FOV: 45 degrees: 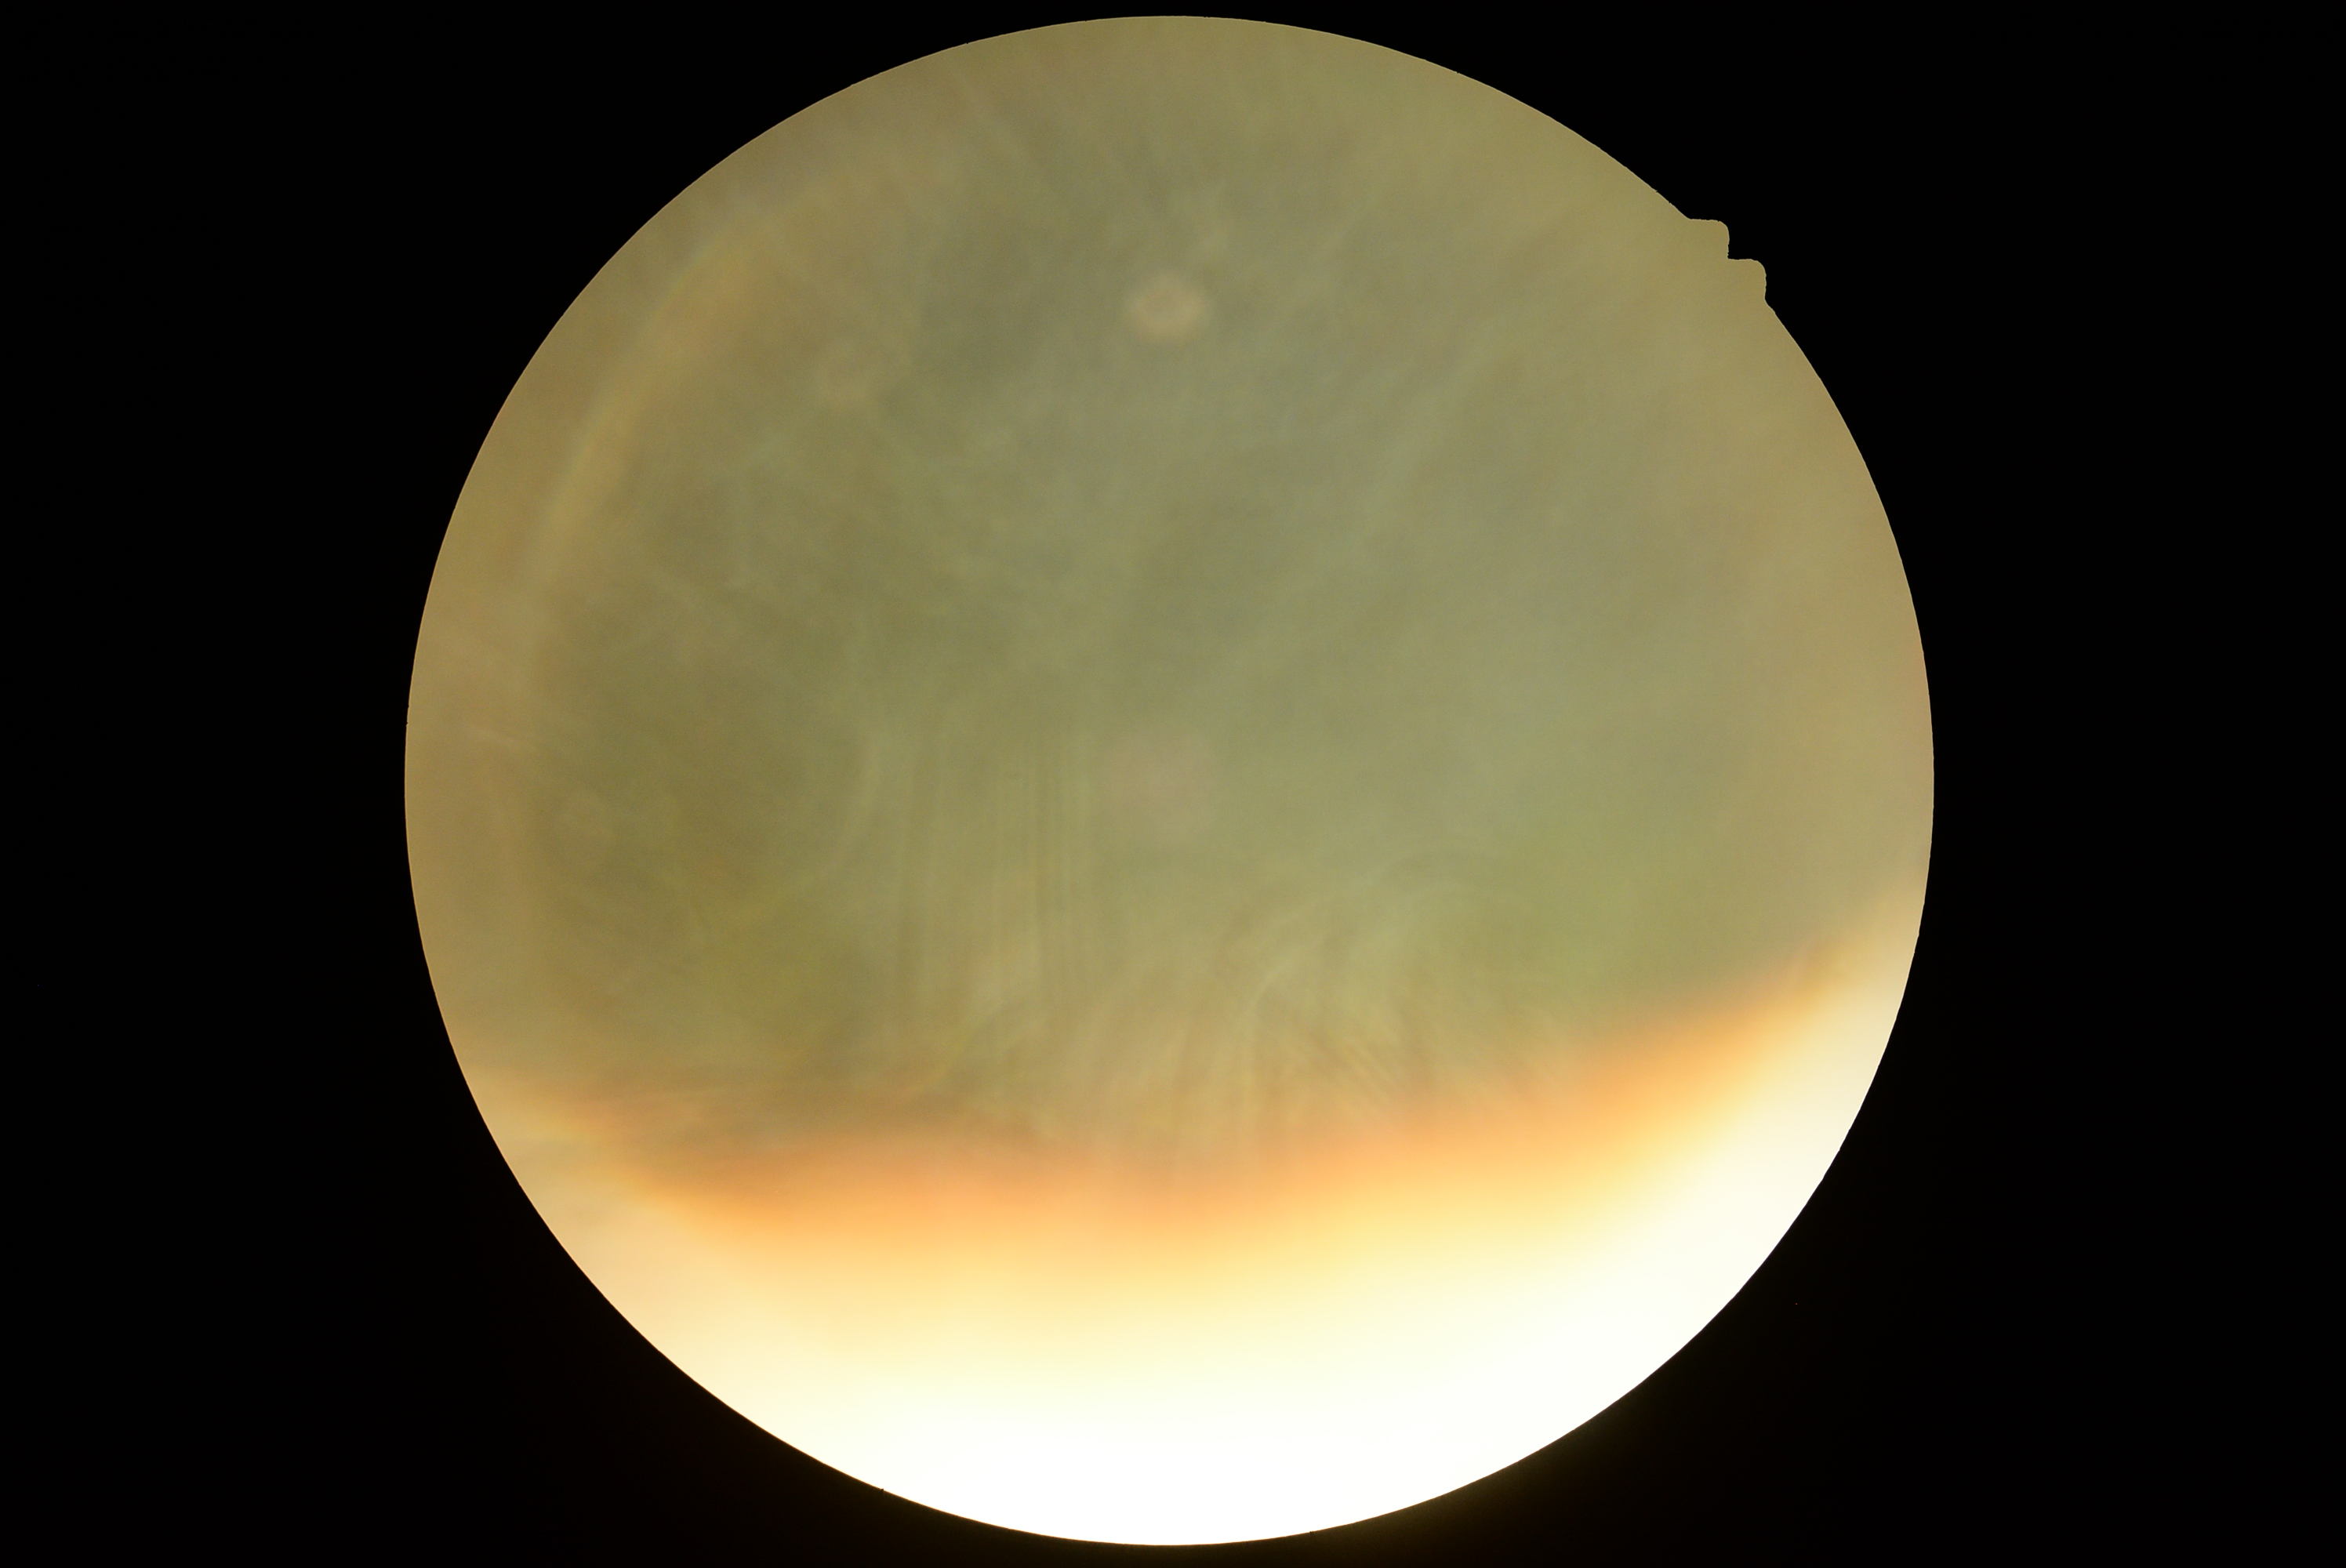
dr_grade: ungradable